Modified Davis grading · camera: NIDEK AFC-230 · 848x848 · posterior pole photograph · nonmydriatic
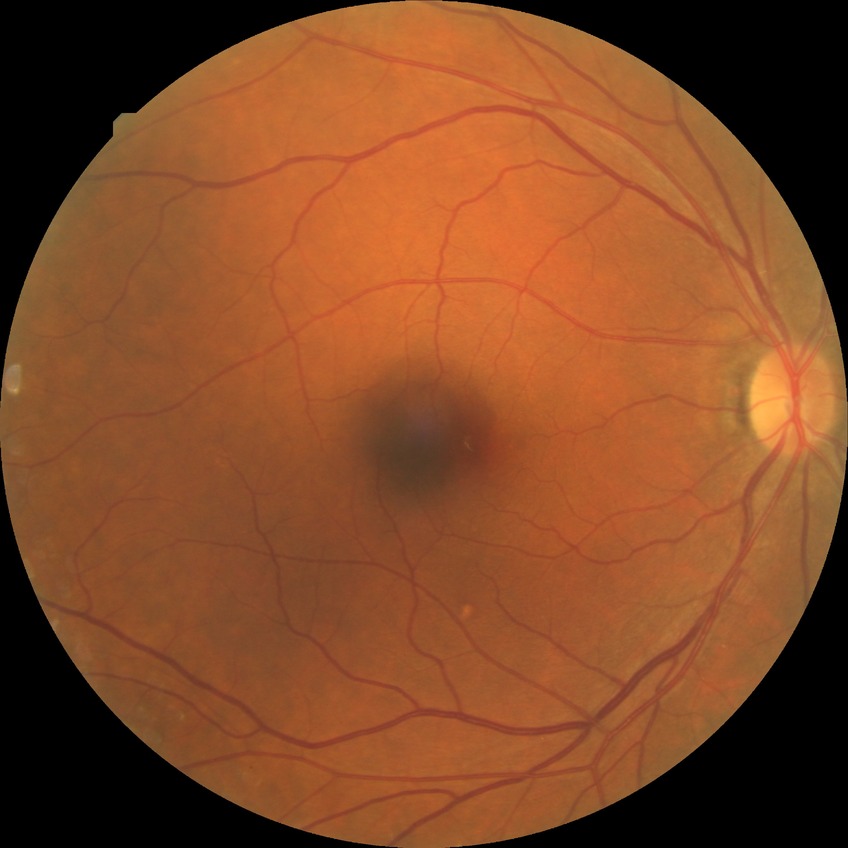
diabetic retinopathy (DR)@no diabetic retinopathy (NDR).